CFP · 45° field of view:
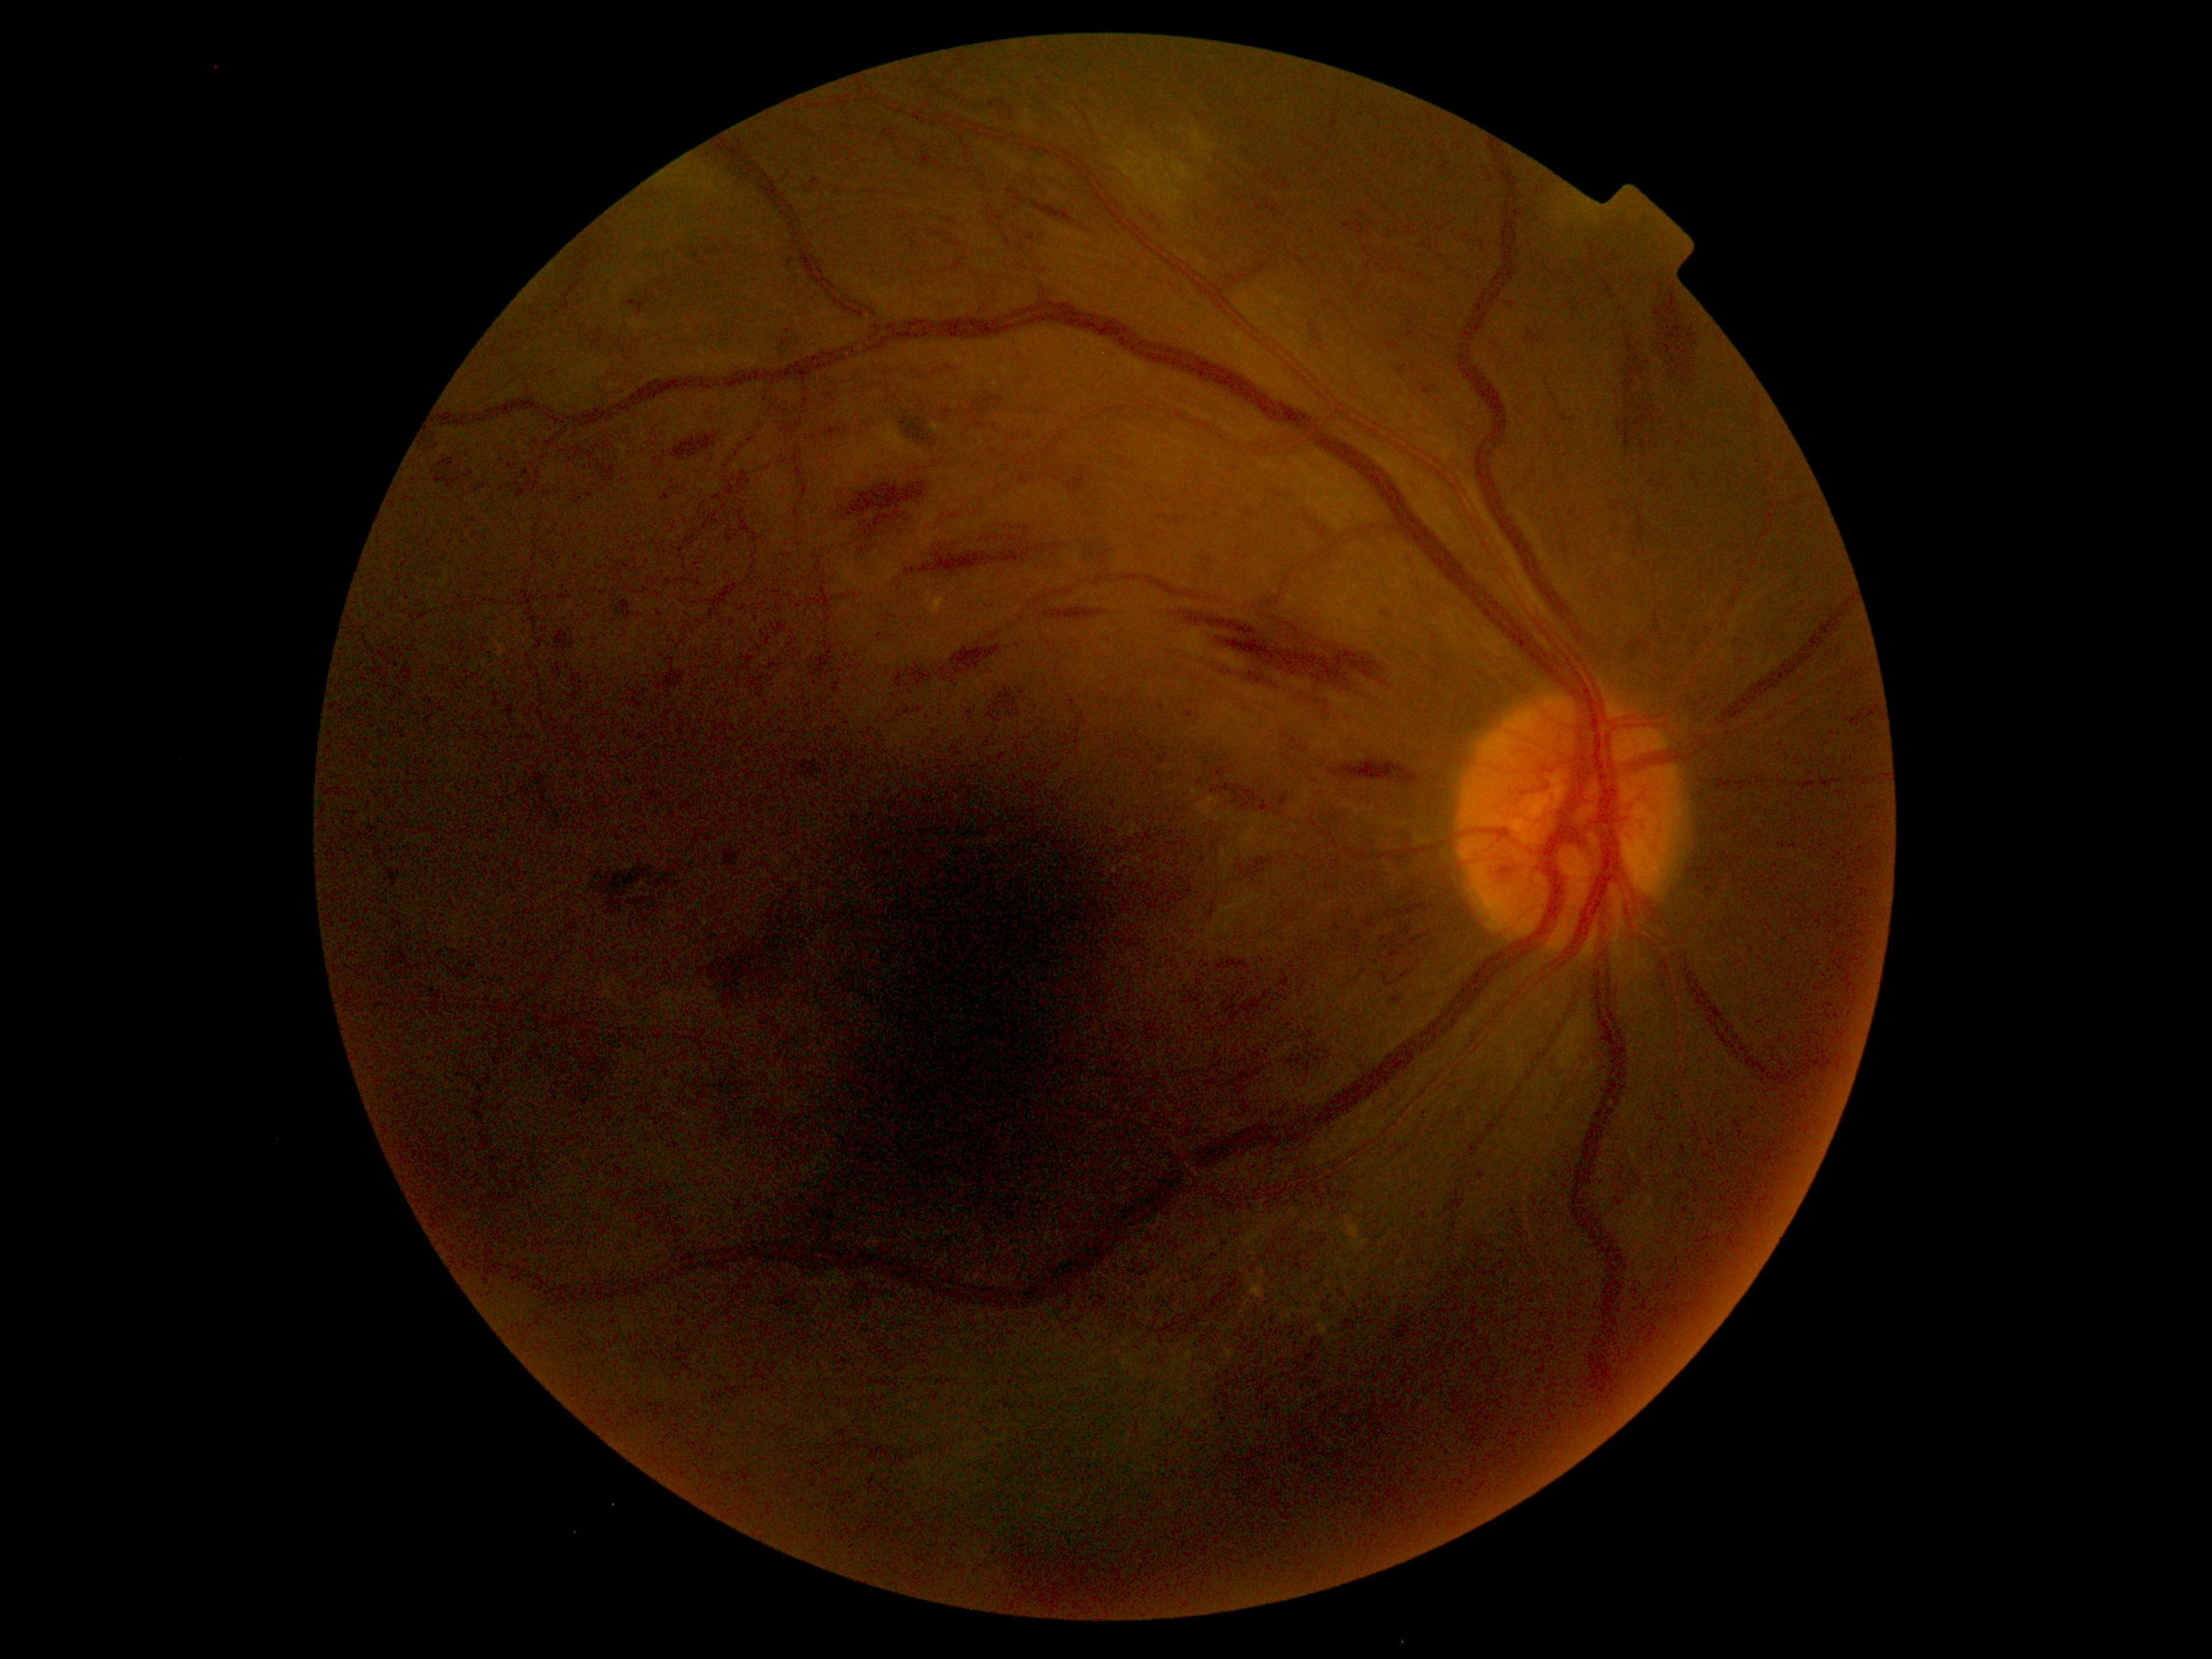

Diabetic retinopathy grade is 4 (PDR) — neovascularization and/or vitreous/pre-retinal hemorrhage.